2228 x 1652 pixels · 50-degree field of view:
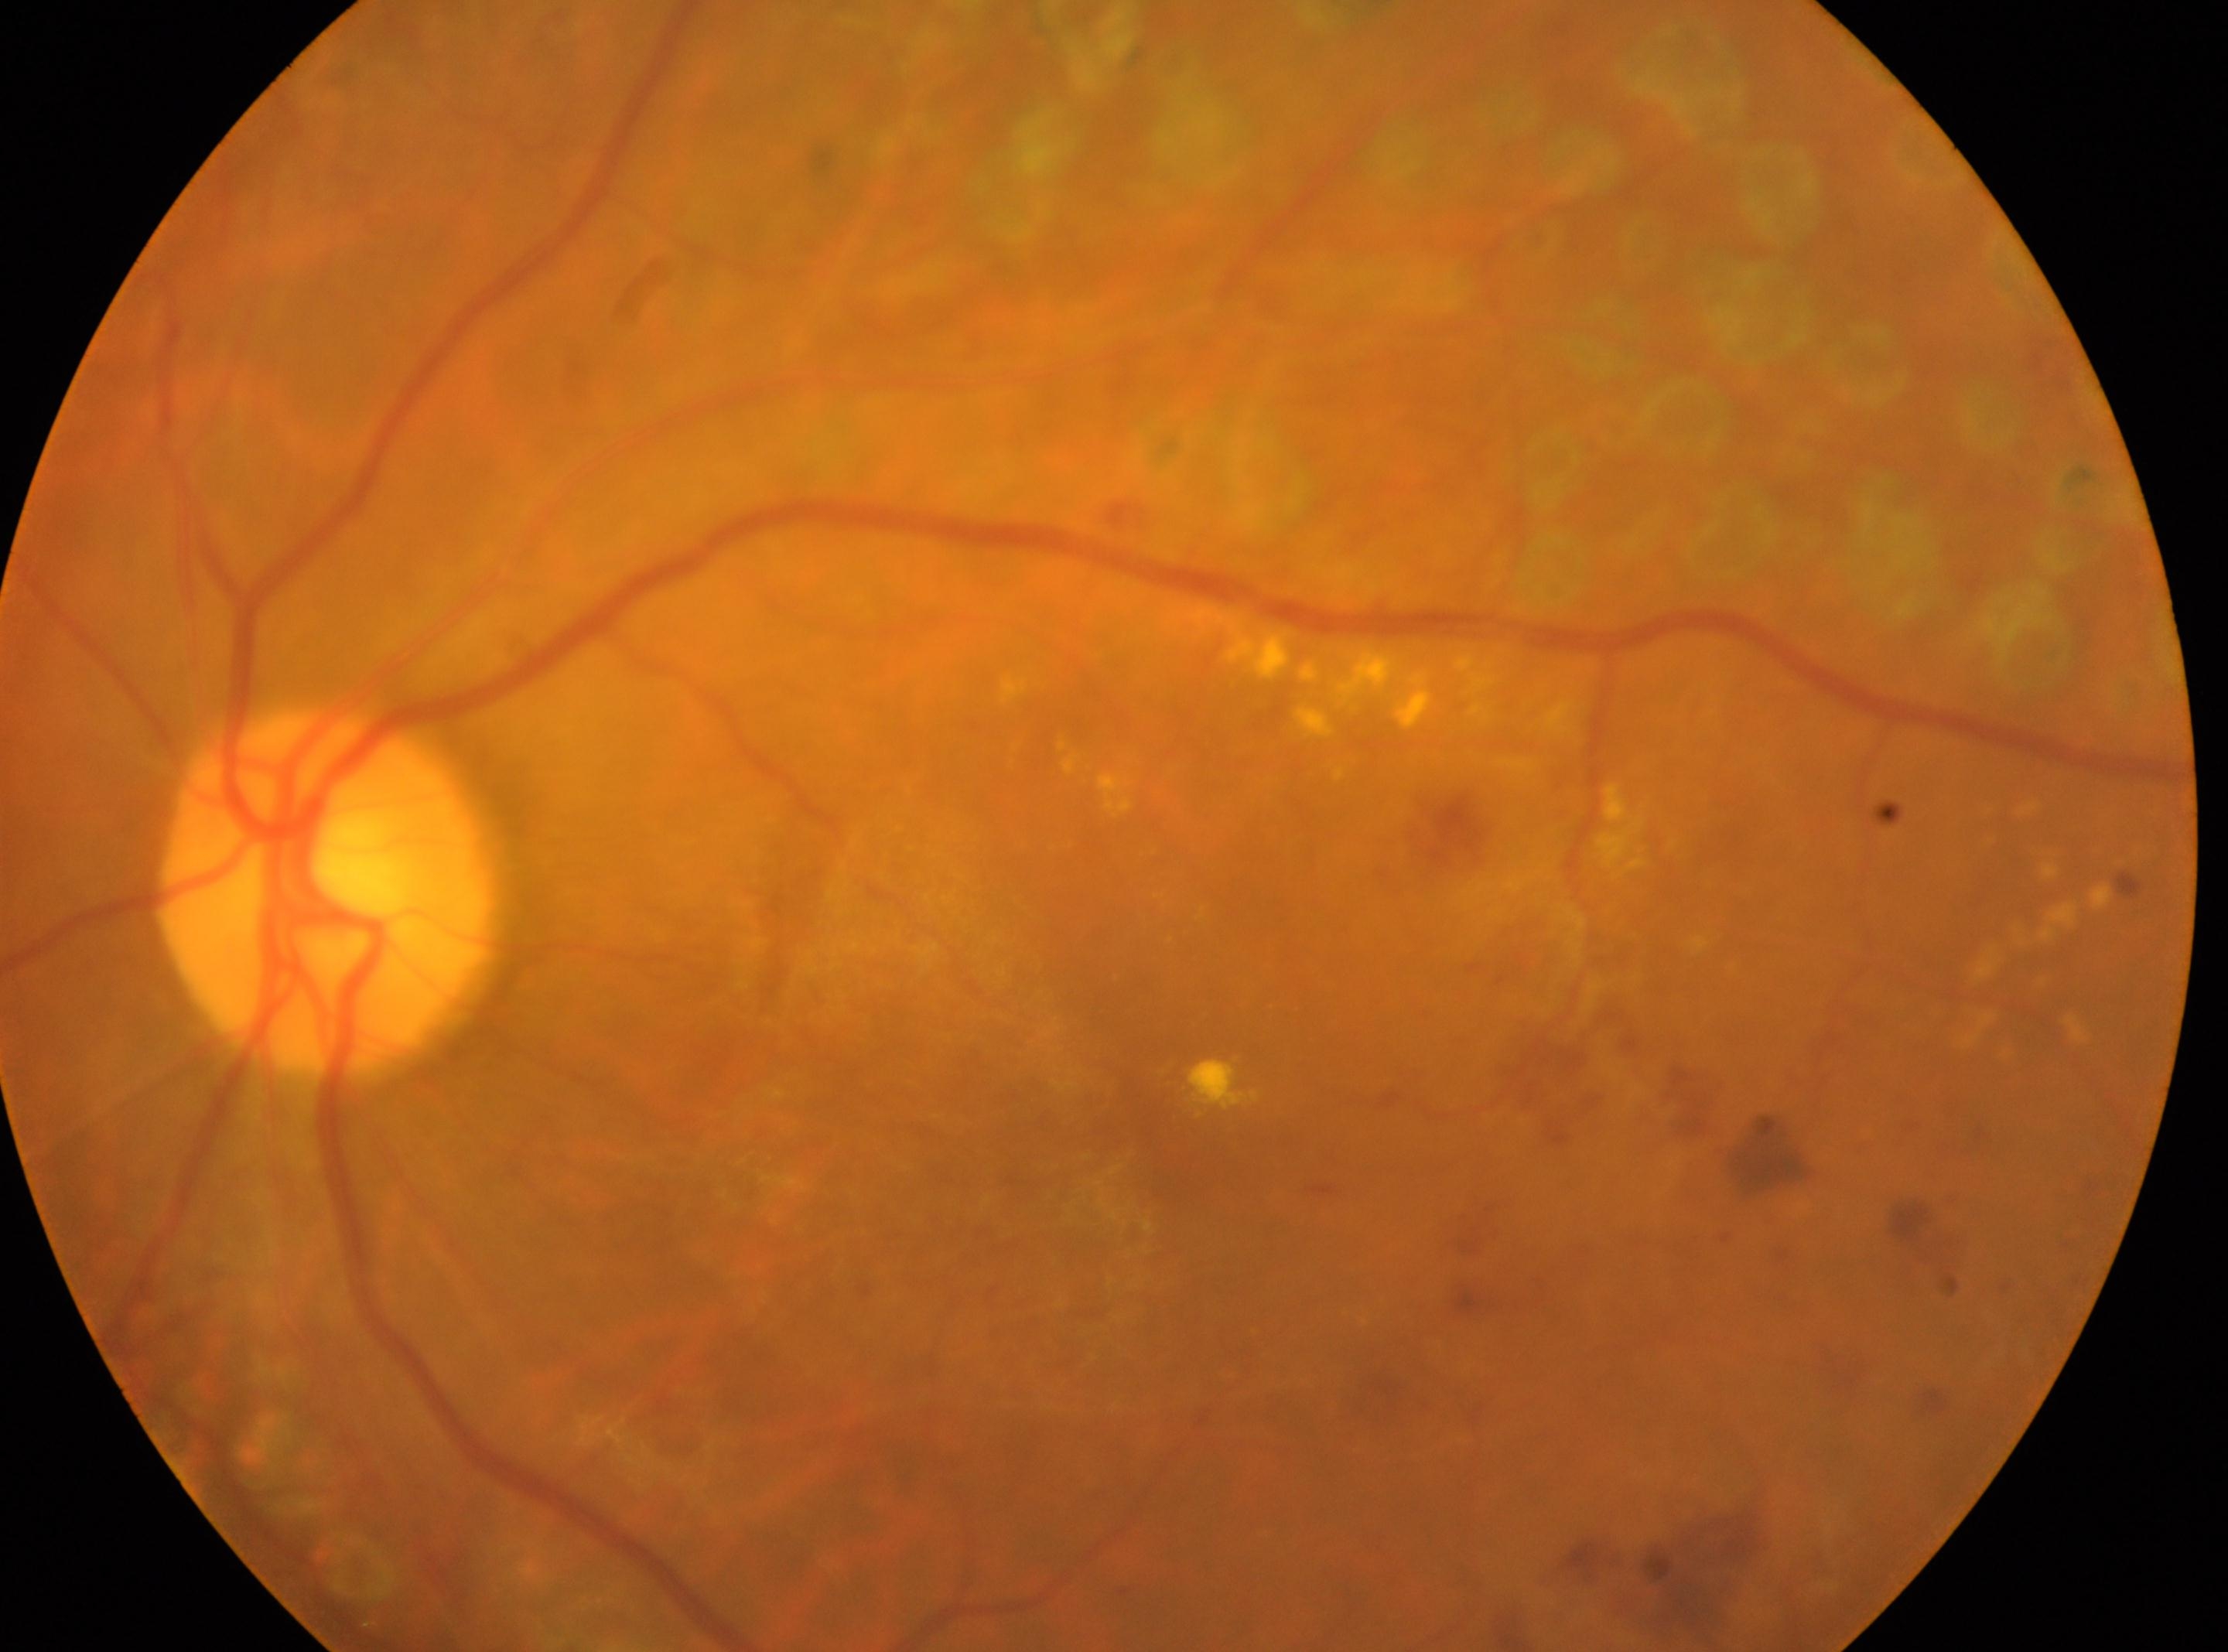
Fovea center: (x: 1164, y: 1132). Eye: oculus sinister. Optic nerve head: (x: 325, y: 889). Diabetic retinopathy severity is post-laser DR.